Image size 1932x1932
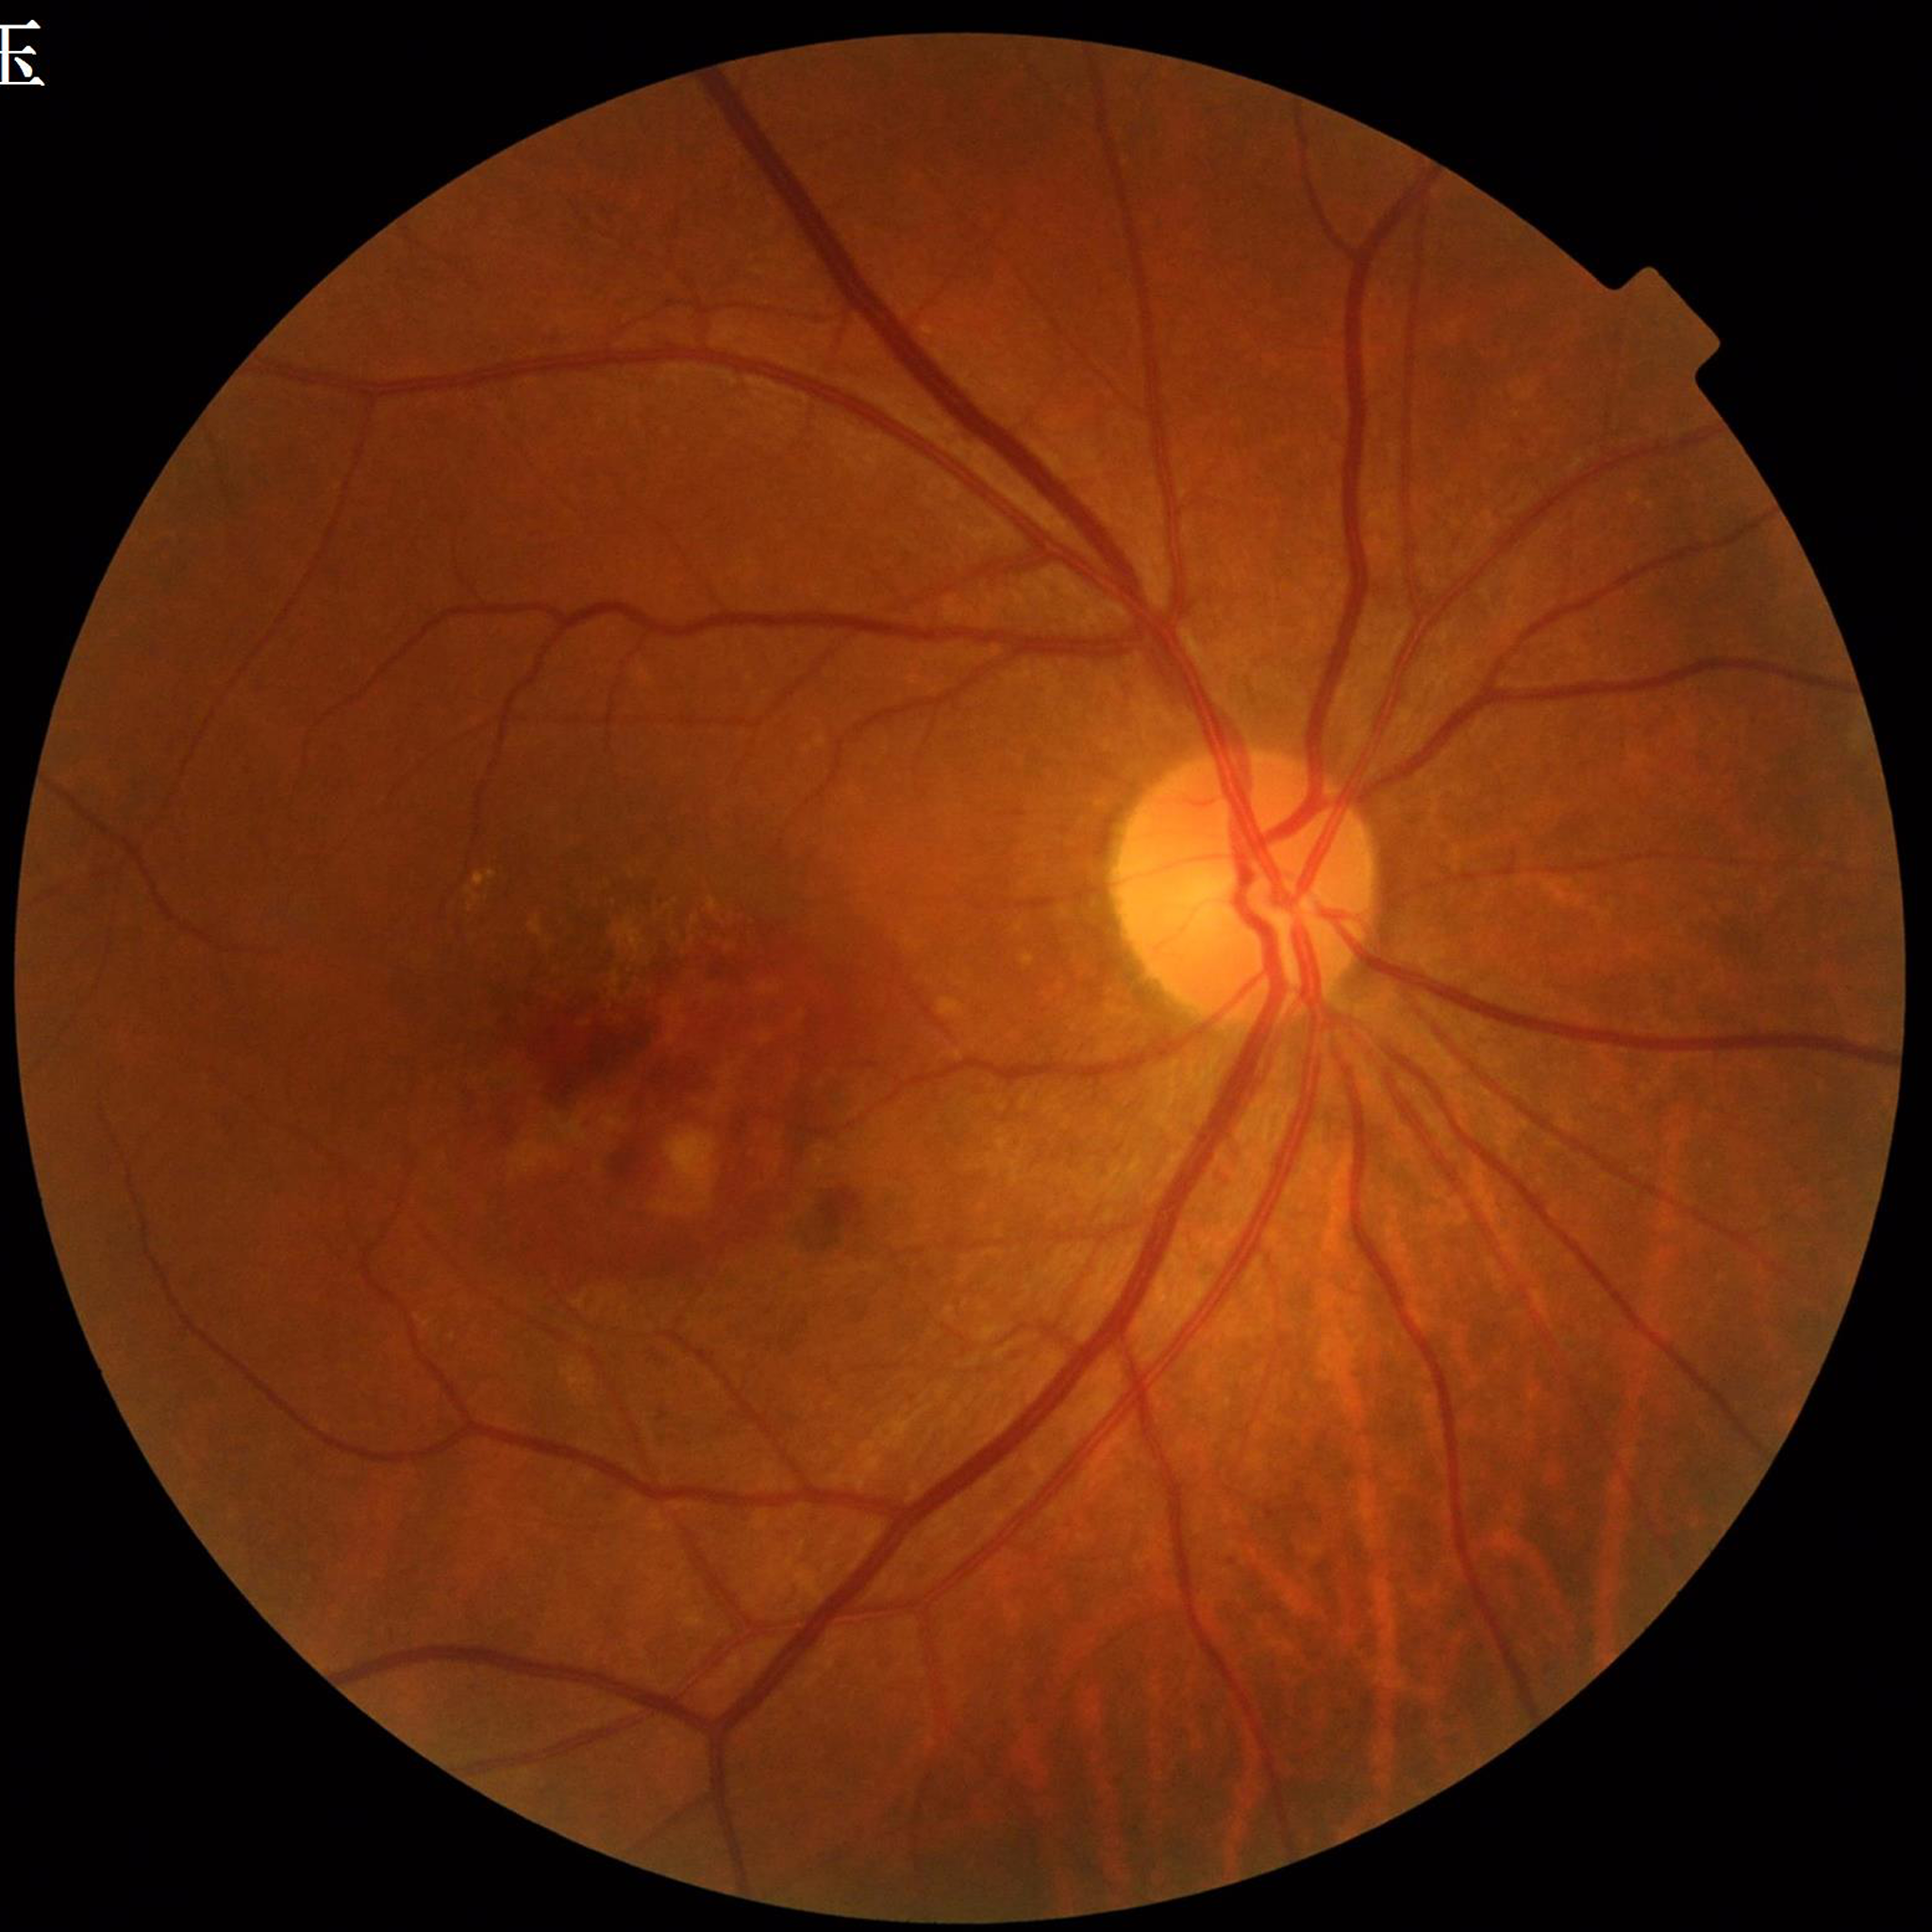

Color fundus photograph from a patient diagnosed with age-related macular degeneration. Quality assessment: illumination and color satisfactory, no blur, contrast adequate.